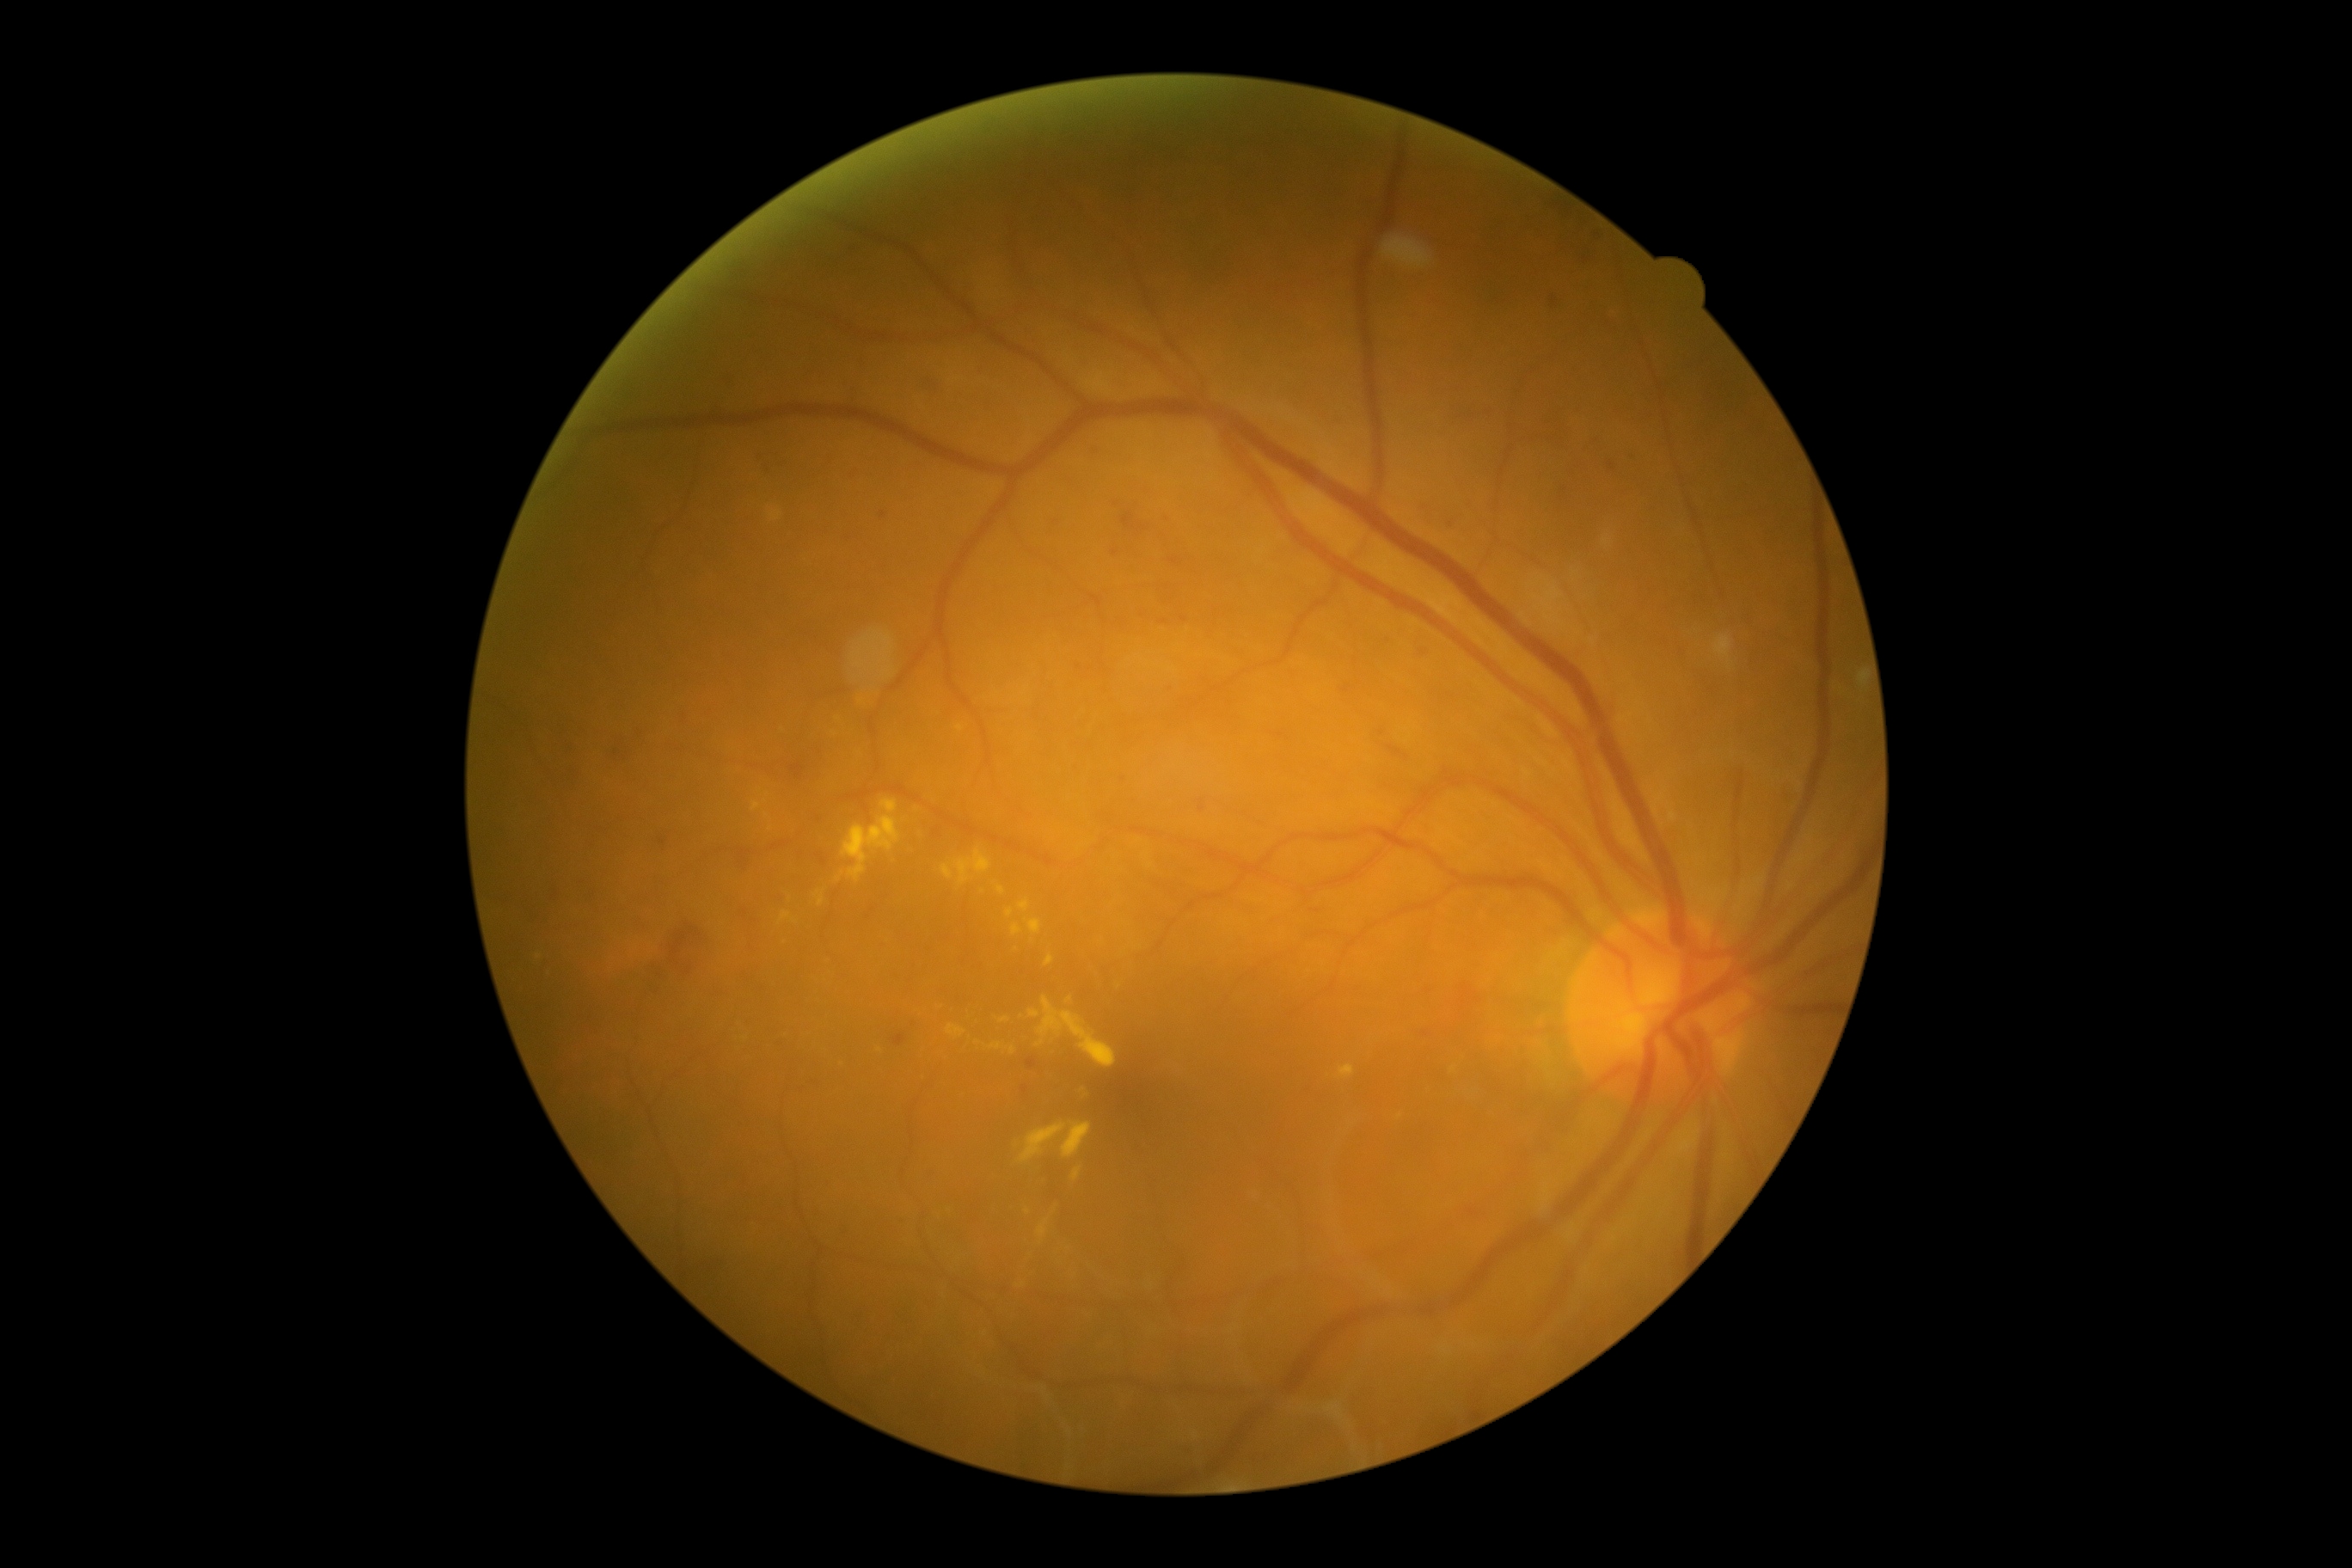 Diabetic retinopathy (DR): grade 2 (moderate NPDR) — more than just microaneurysms but less than severe NPDR.